Wide-field fundus photograph of an infant · 640 by 480 pixels: 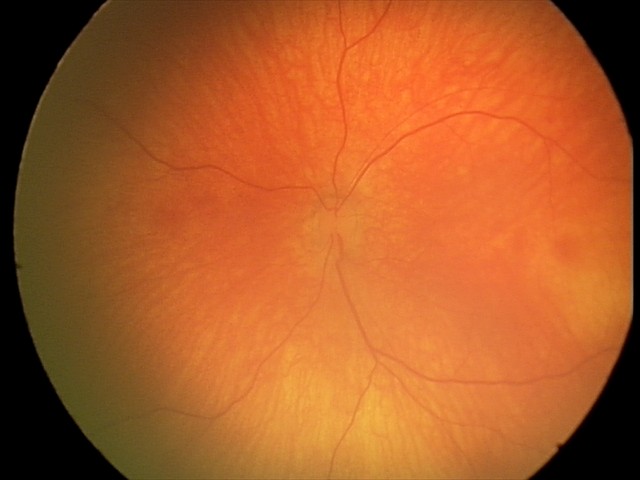

Q: What is the screening diagnosis?
A: normal retinal appearance